Image size 848x848. Graded on the modified Davis scale:
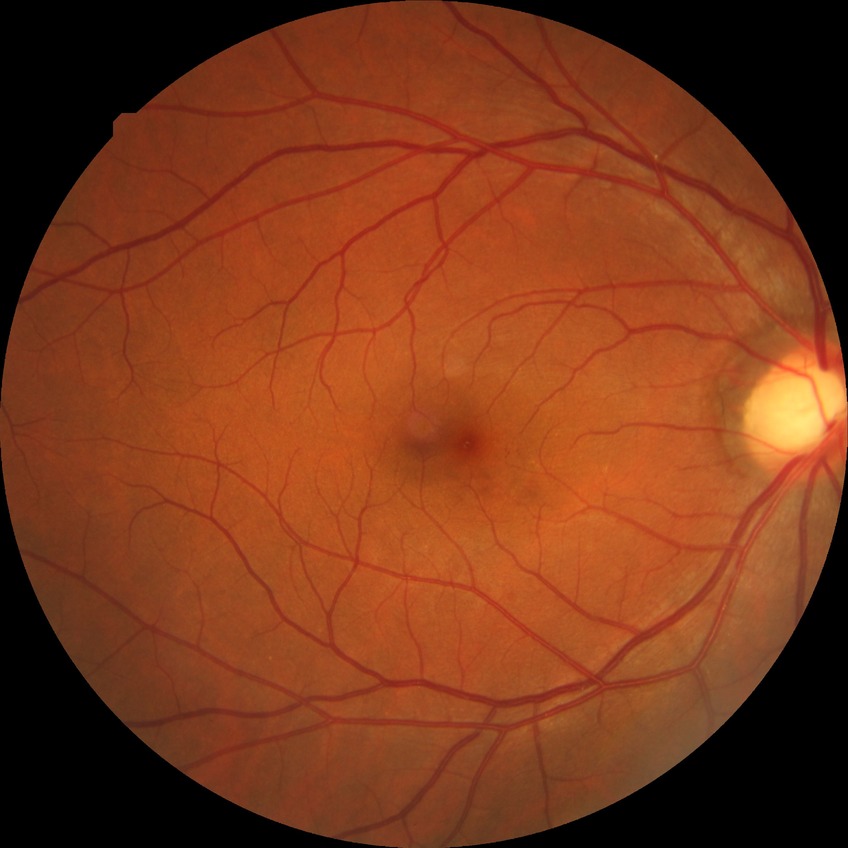 Diabetic retinopathy (DR) is no diabetic retinopathy (NDR).